1240x1240. Pediatric retinal photograph (wide-field).
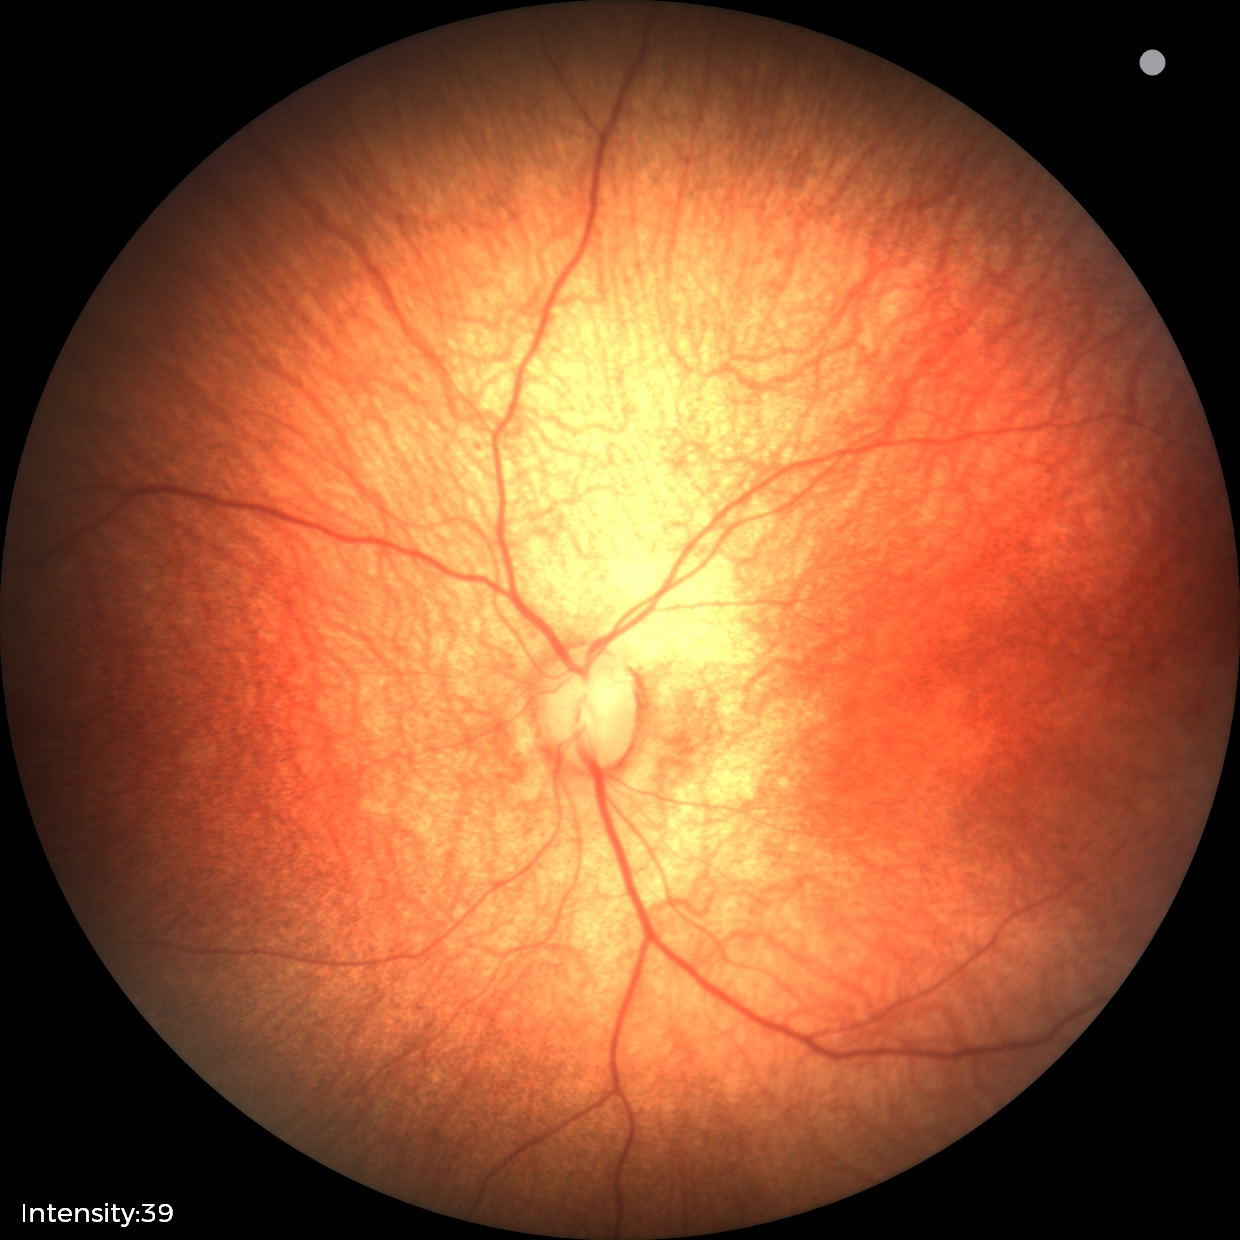 Screening examination diagnosed as physiological.